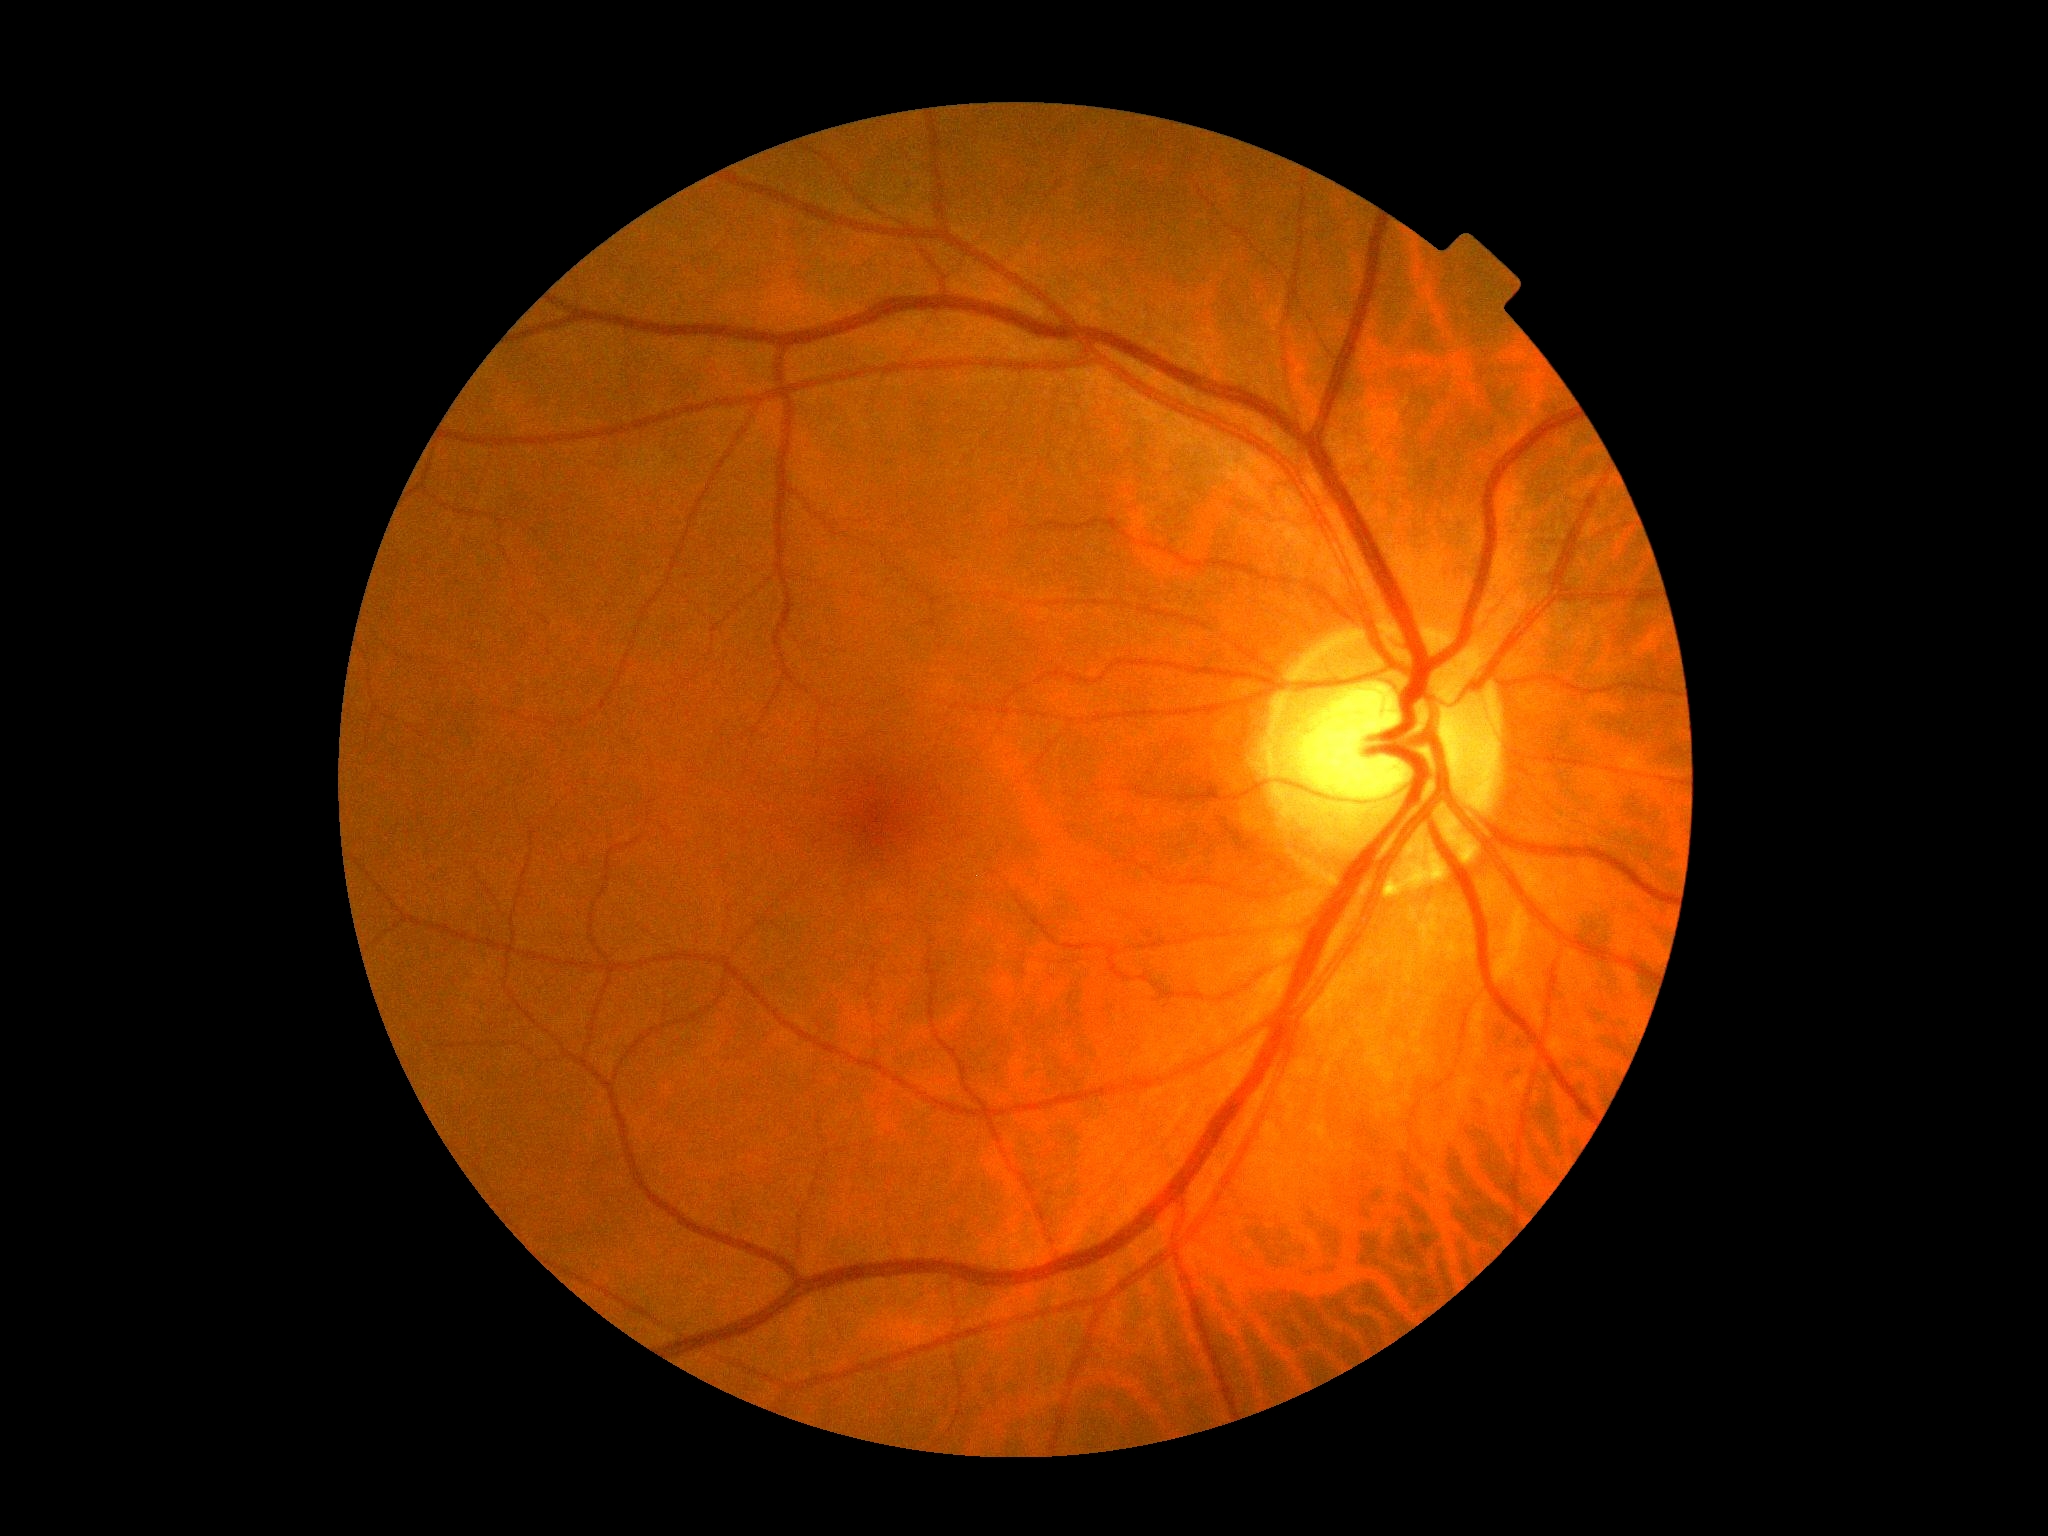
Diabetic retinopathy (DR): grade 0.